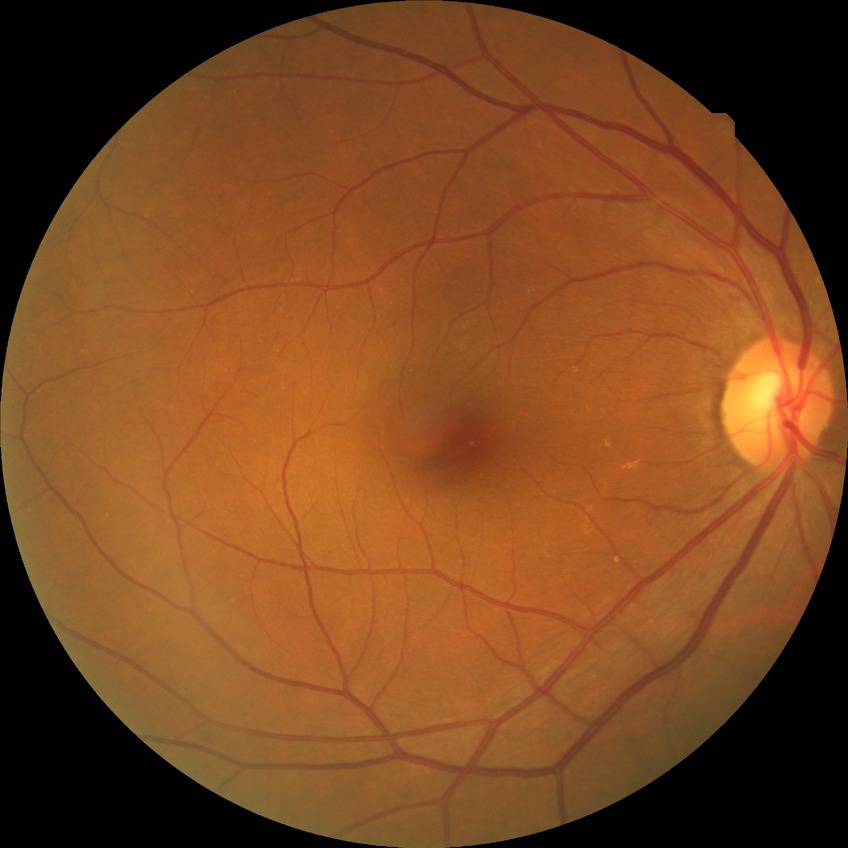
Diabetic retinopathy (DR) is no diabetic retinopathy (NDR).